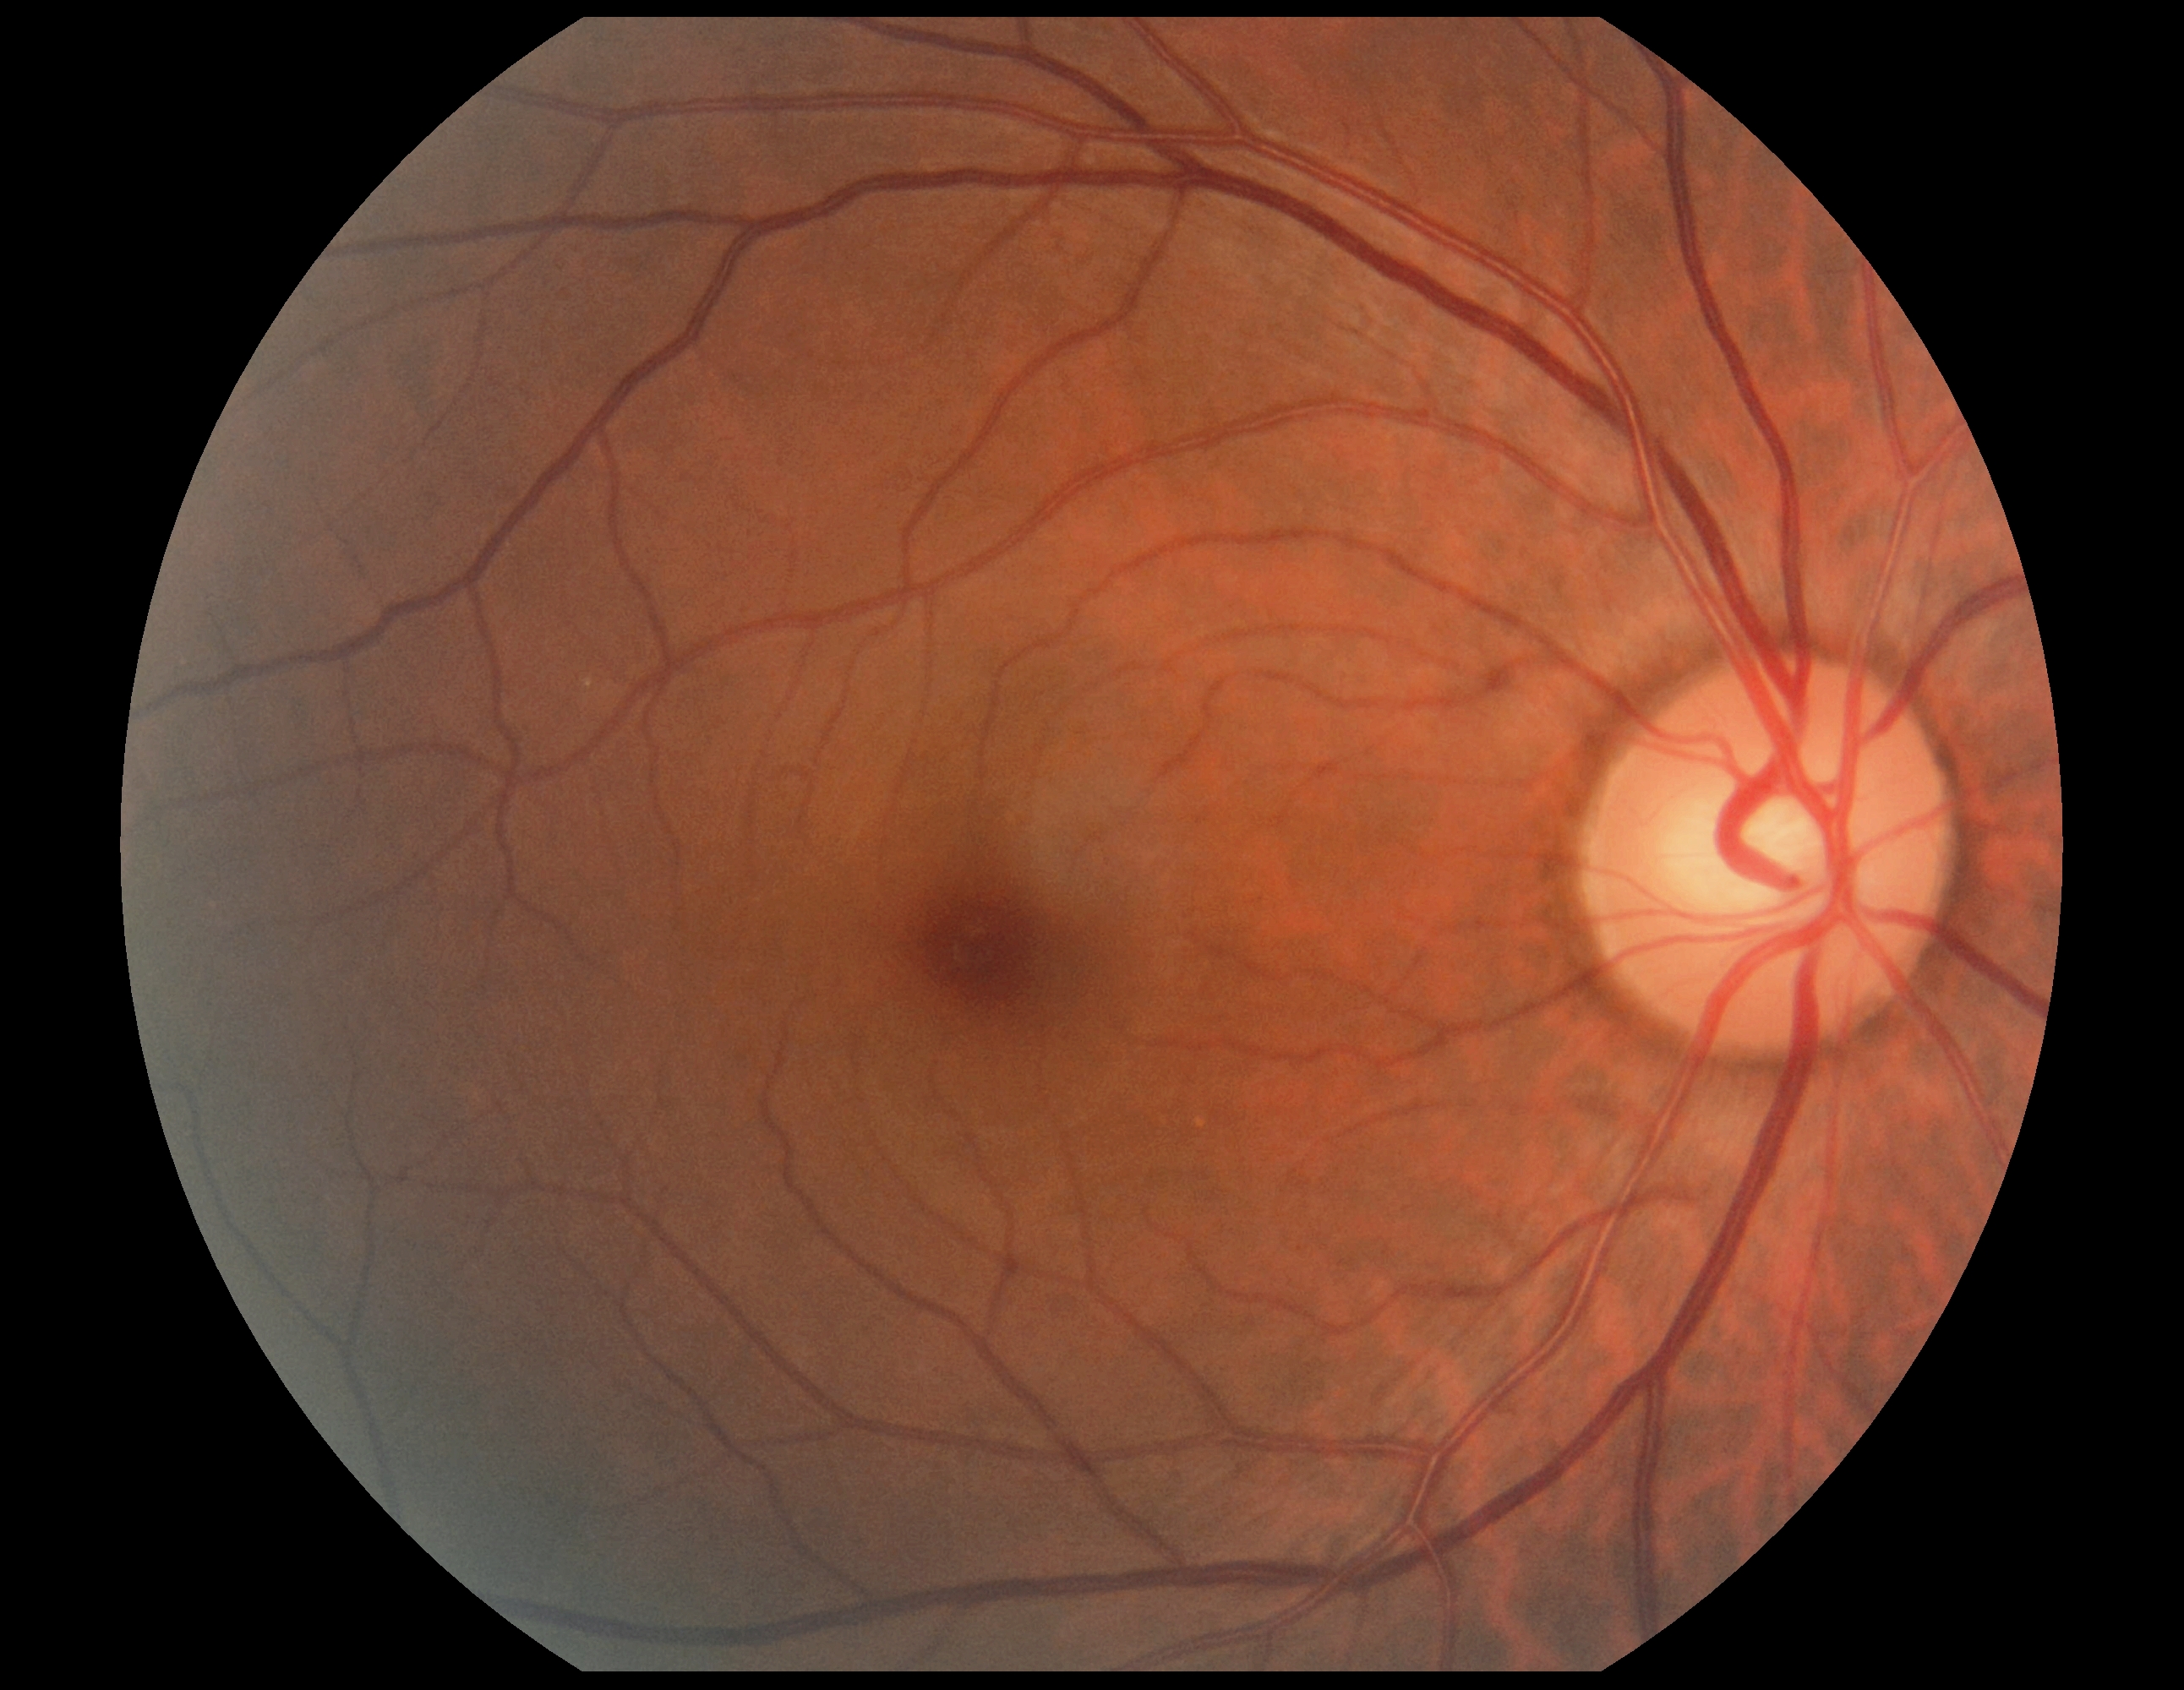
No signs of diabetic retinopathy. DR: 0/4.